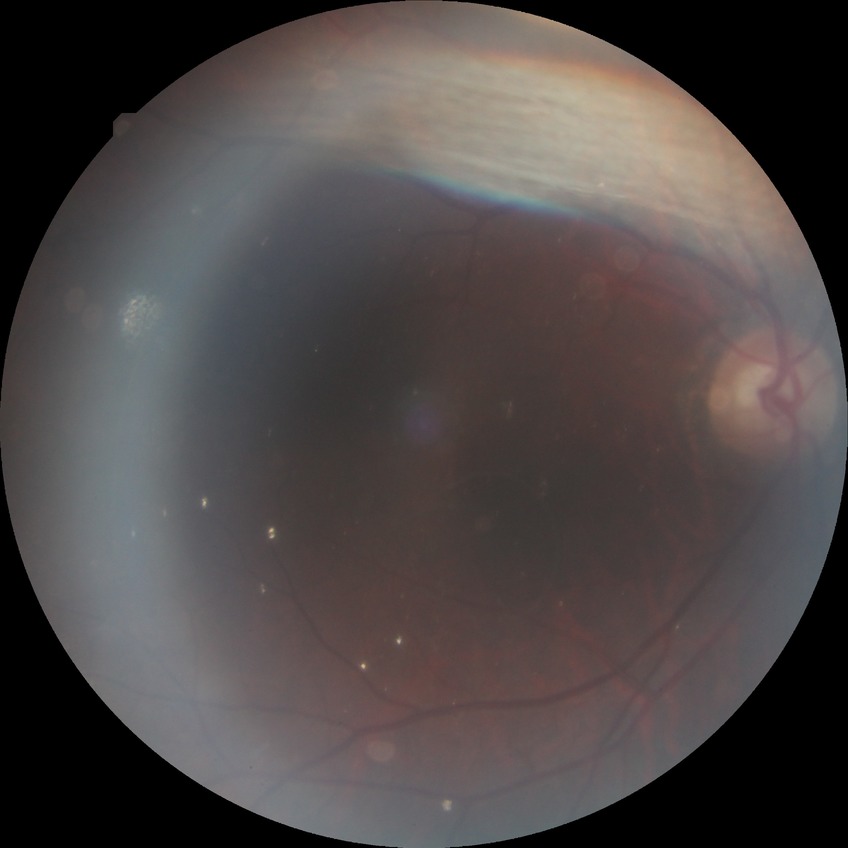 Diabetic retinopathy grade is no diabetic retinopathy.